Color fundus image · 45-degree field of view · image size 2212x1659
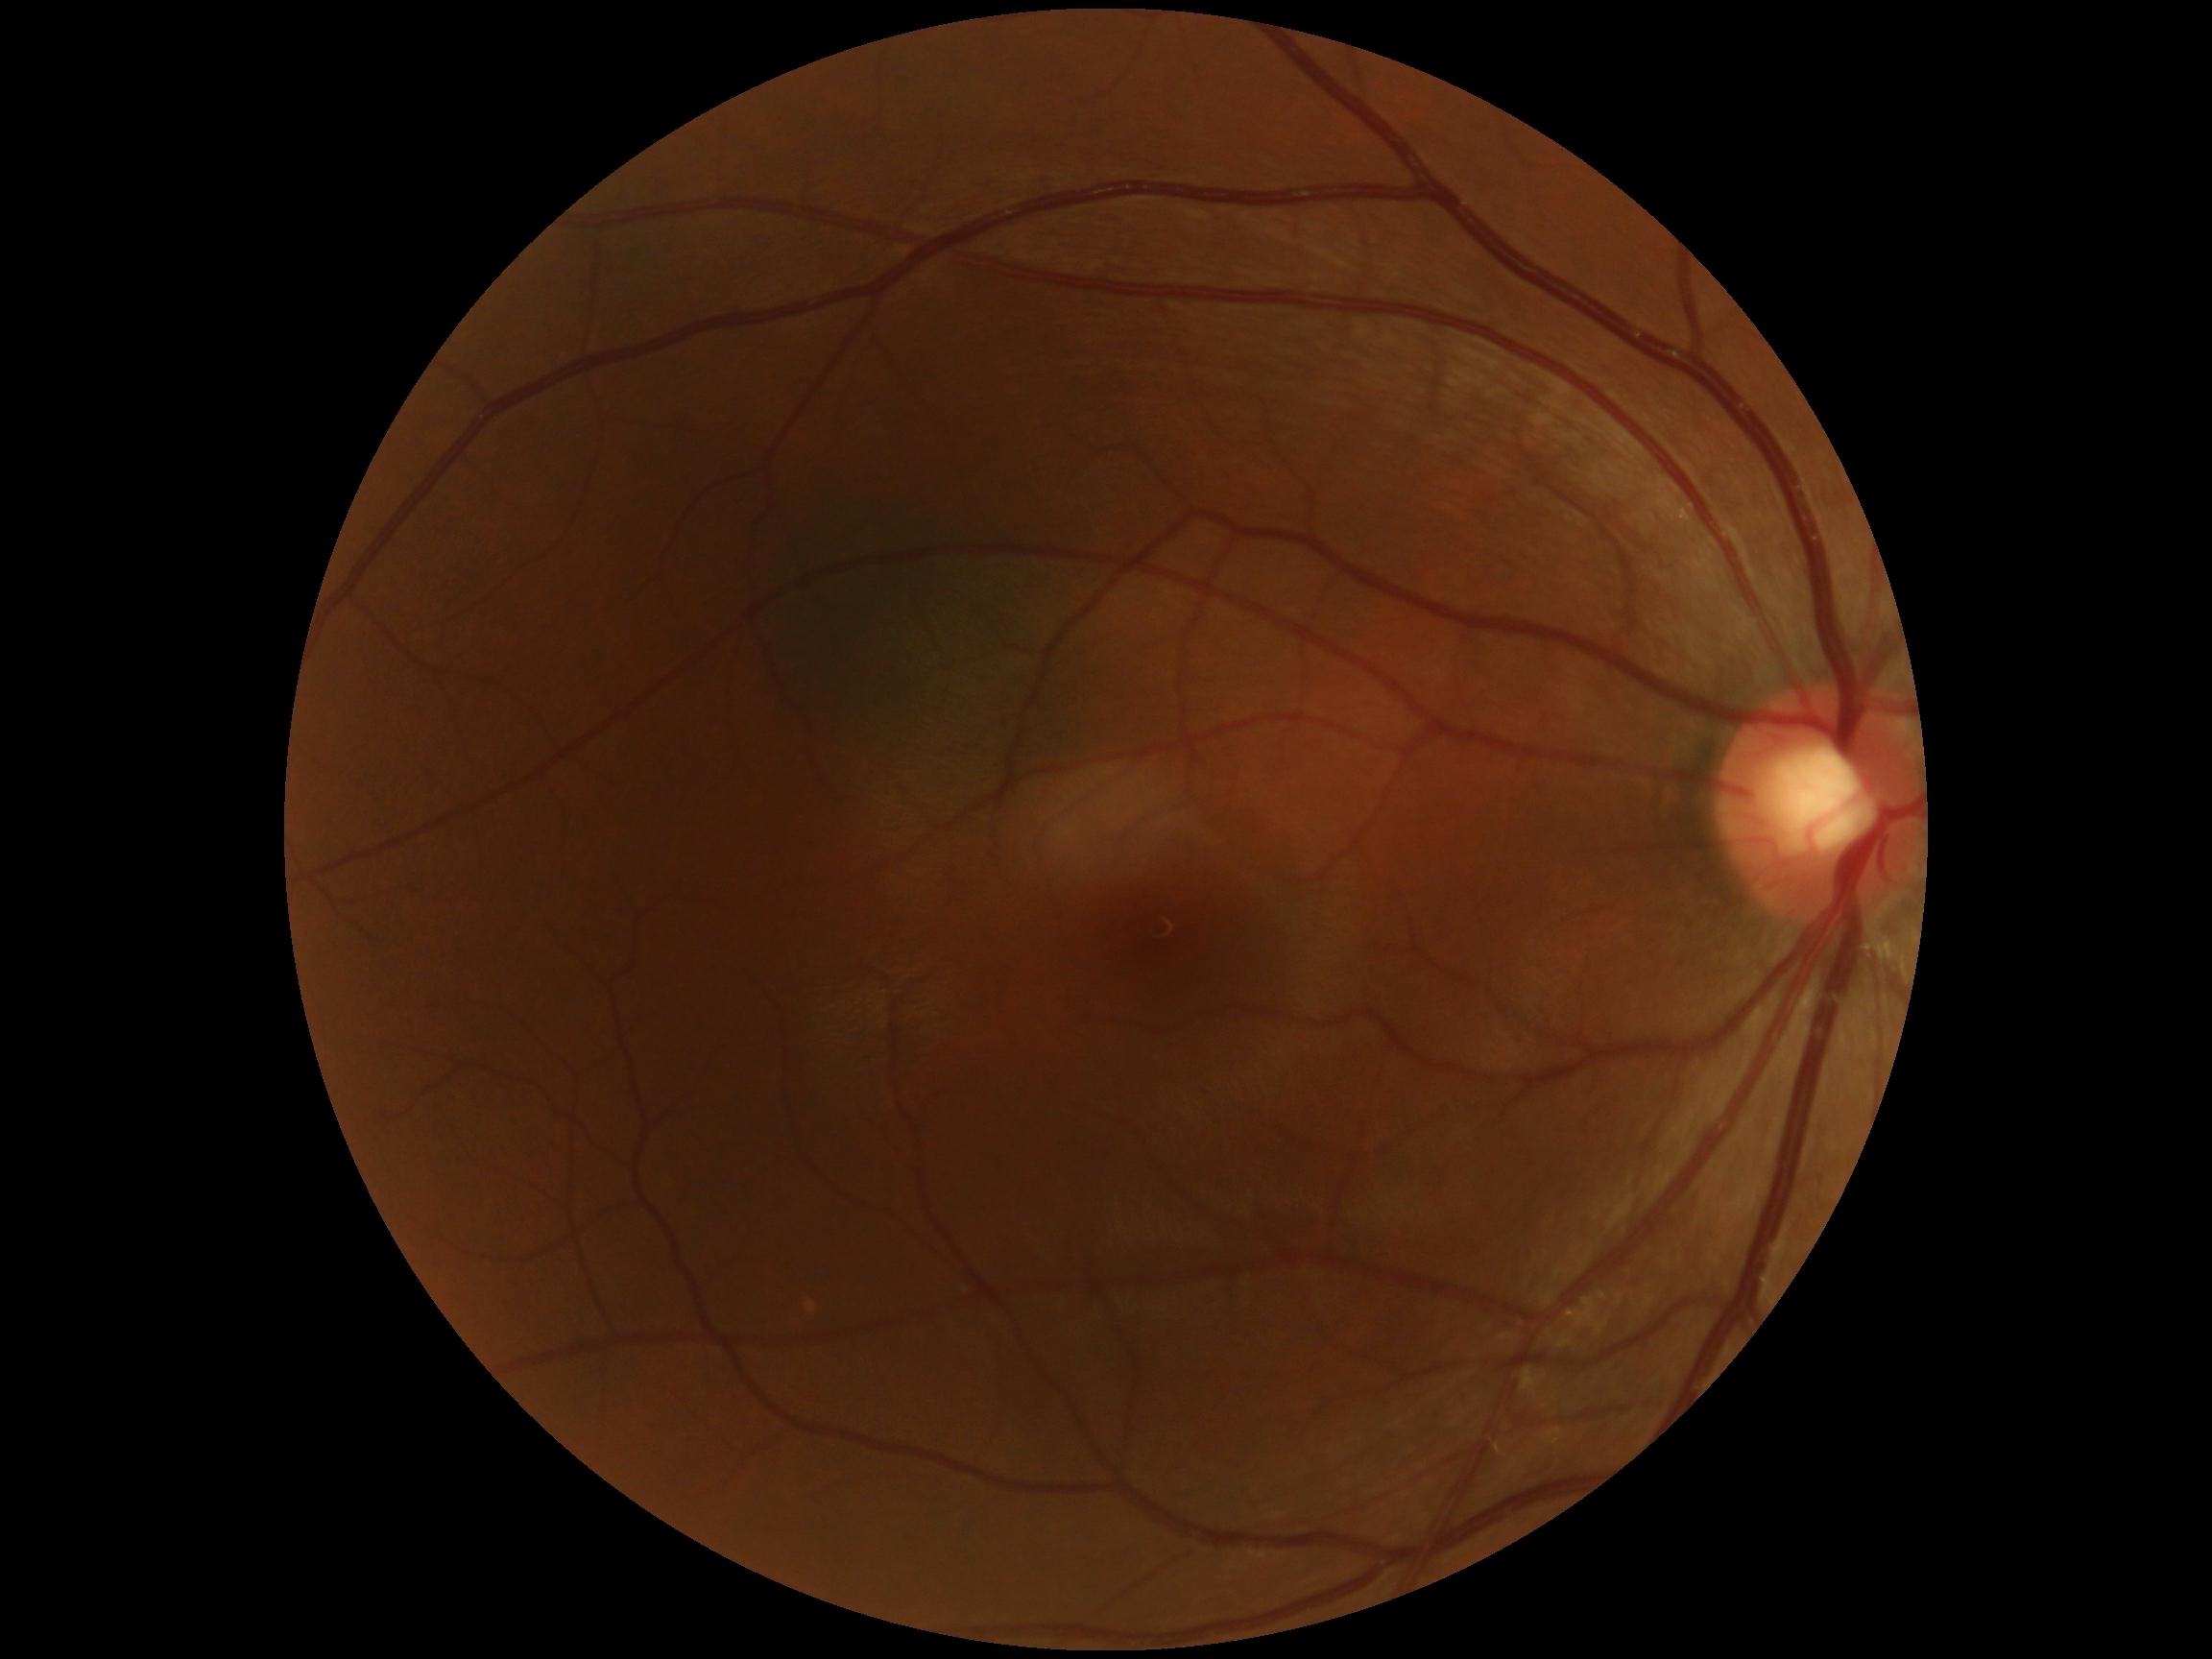 No signs of diabetic retinopathy. DR severity is no apparent retinopathy (grade 0).